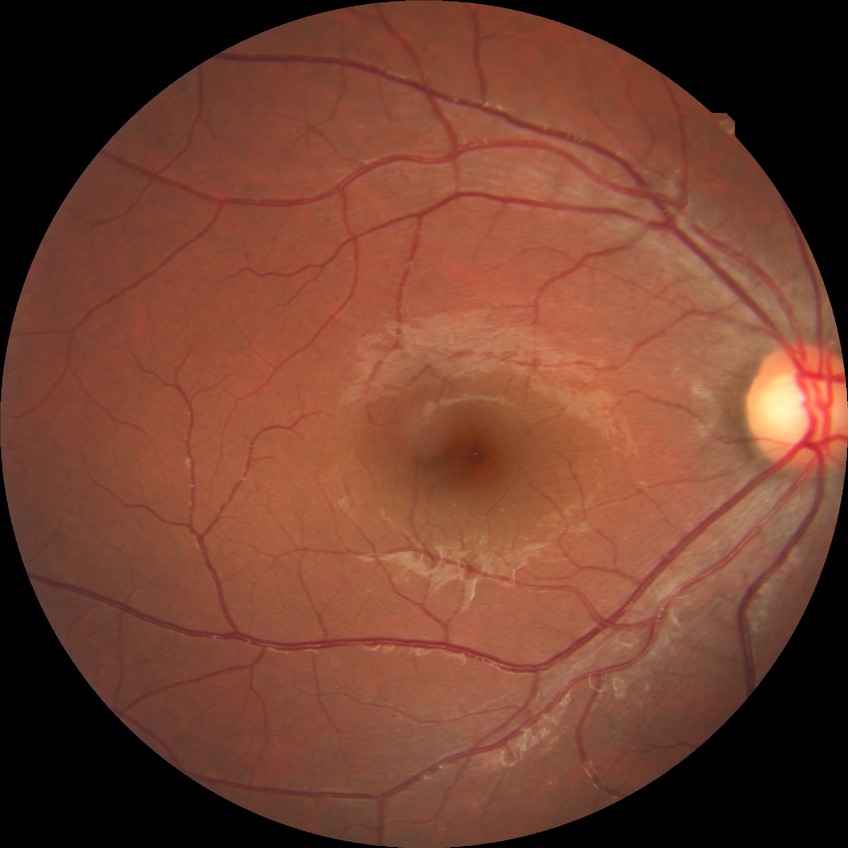
retinopathy stage: no diabetic retinopathy.